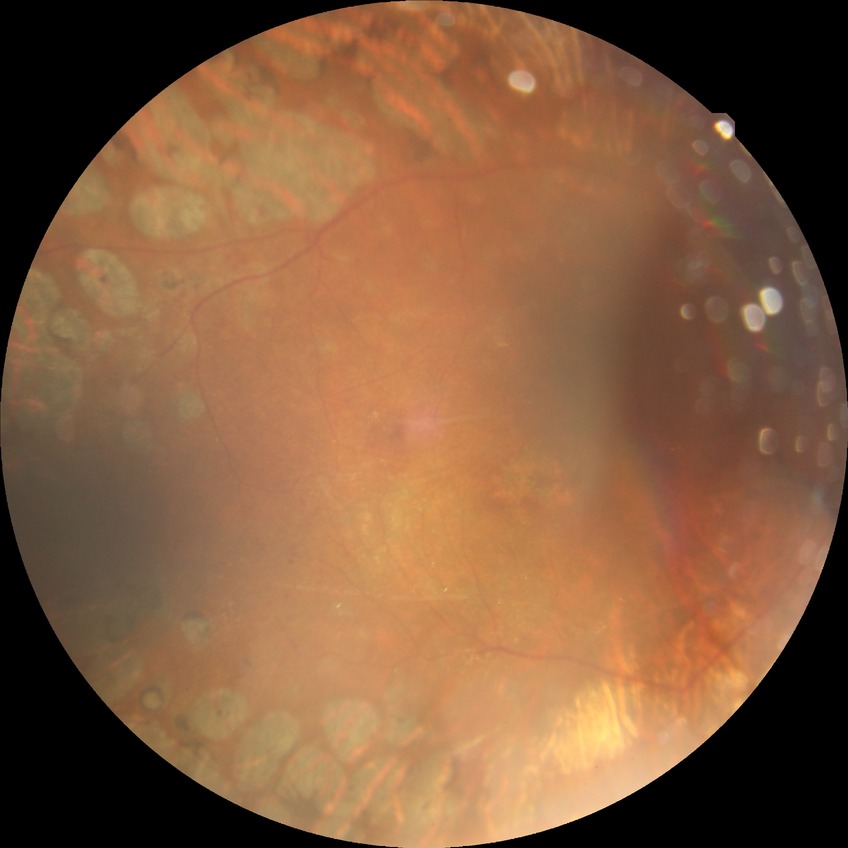

Retinopathy stage is proliferative diabetic retinopathy.